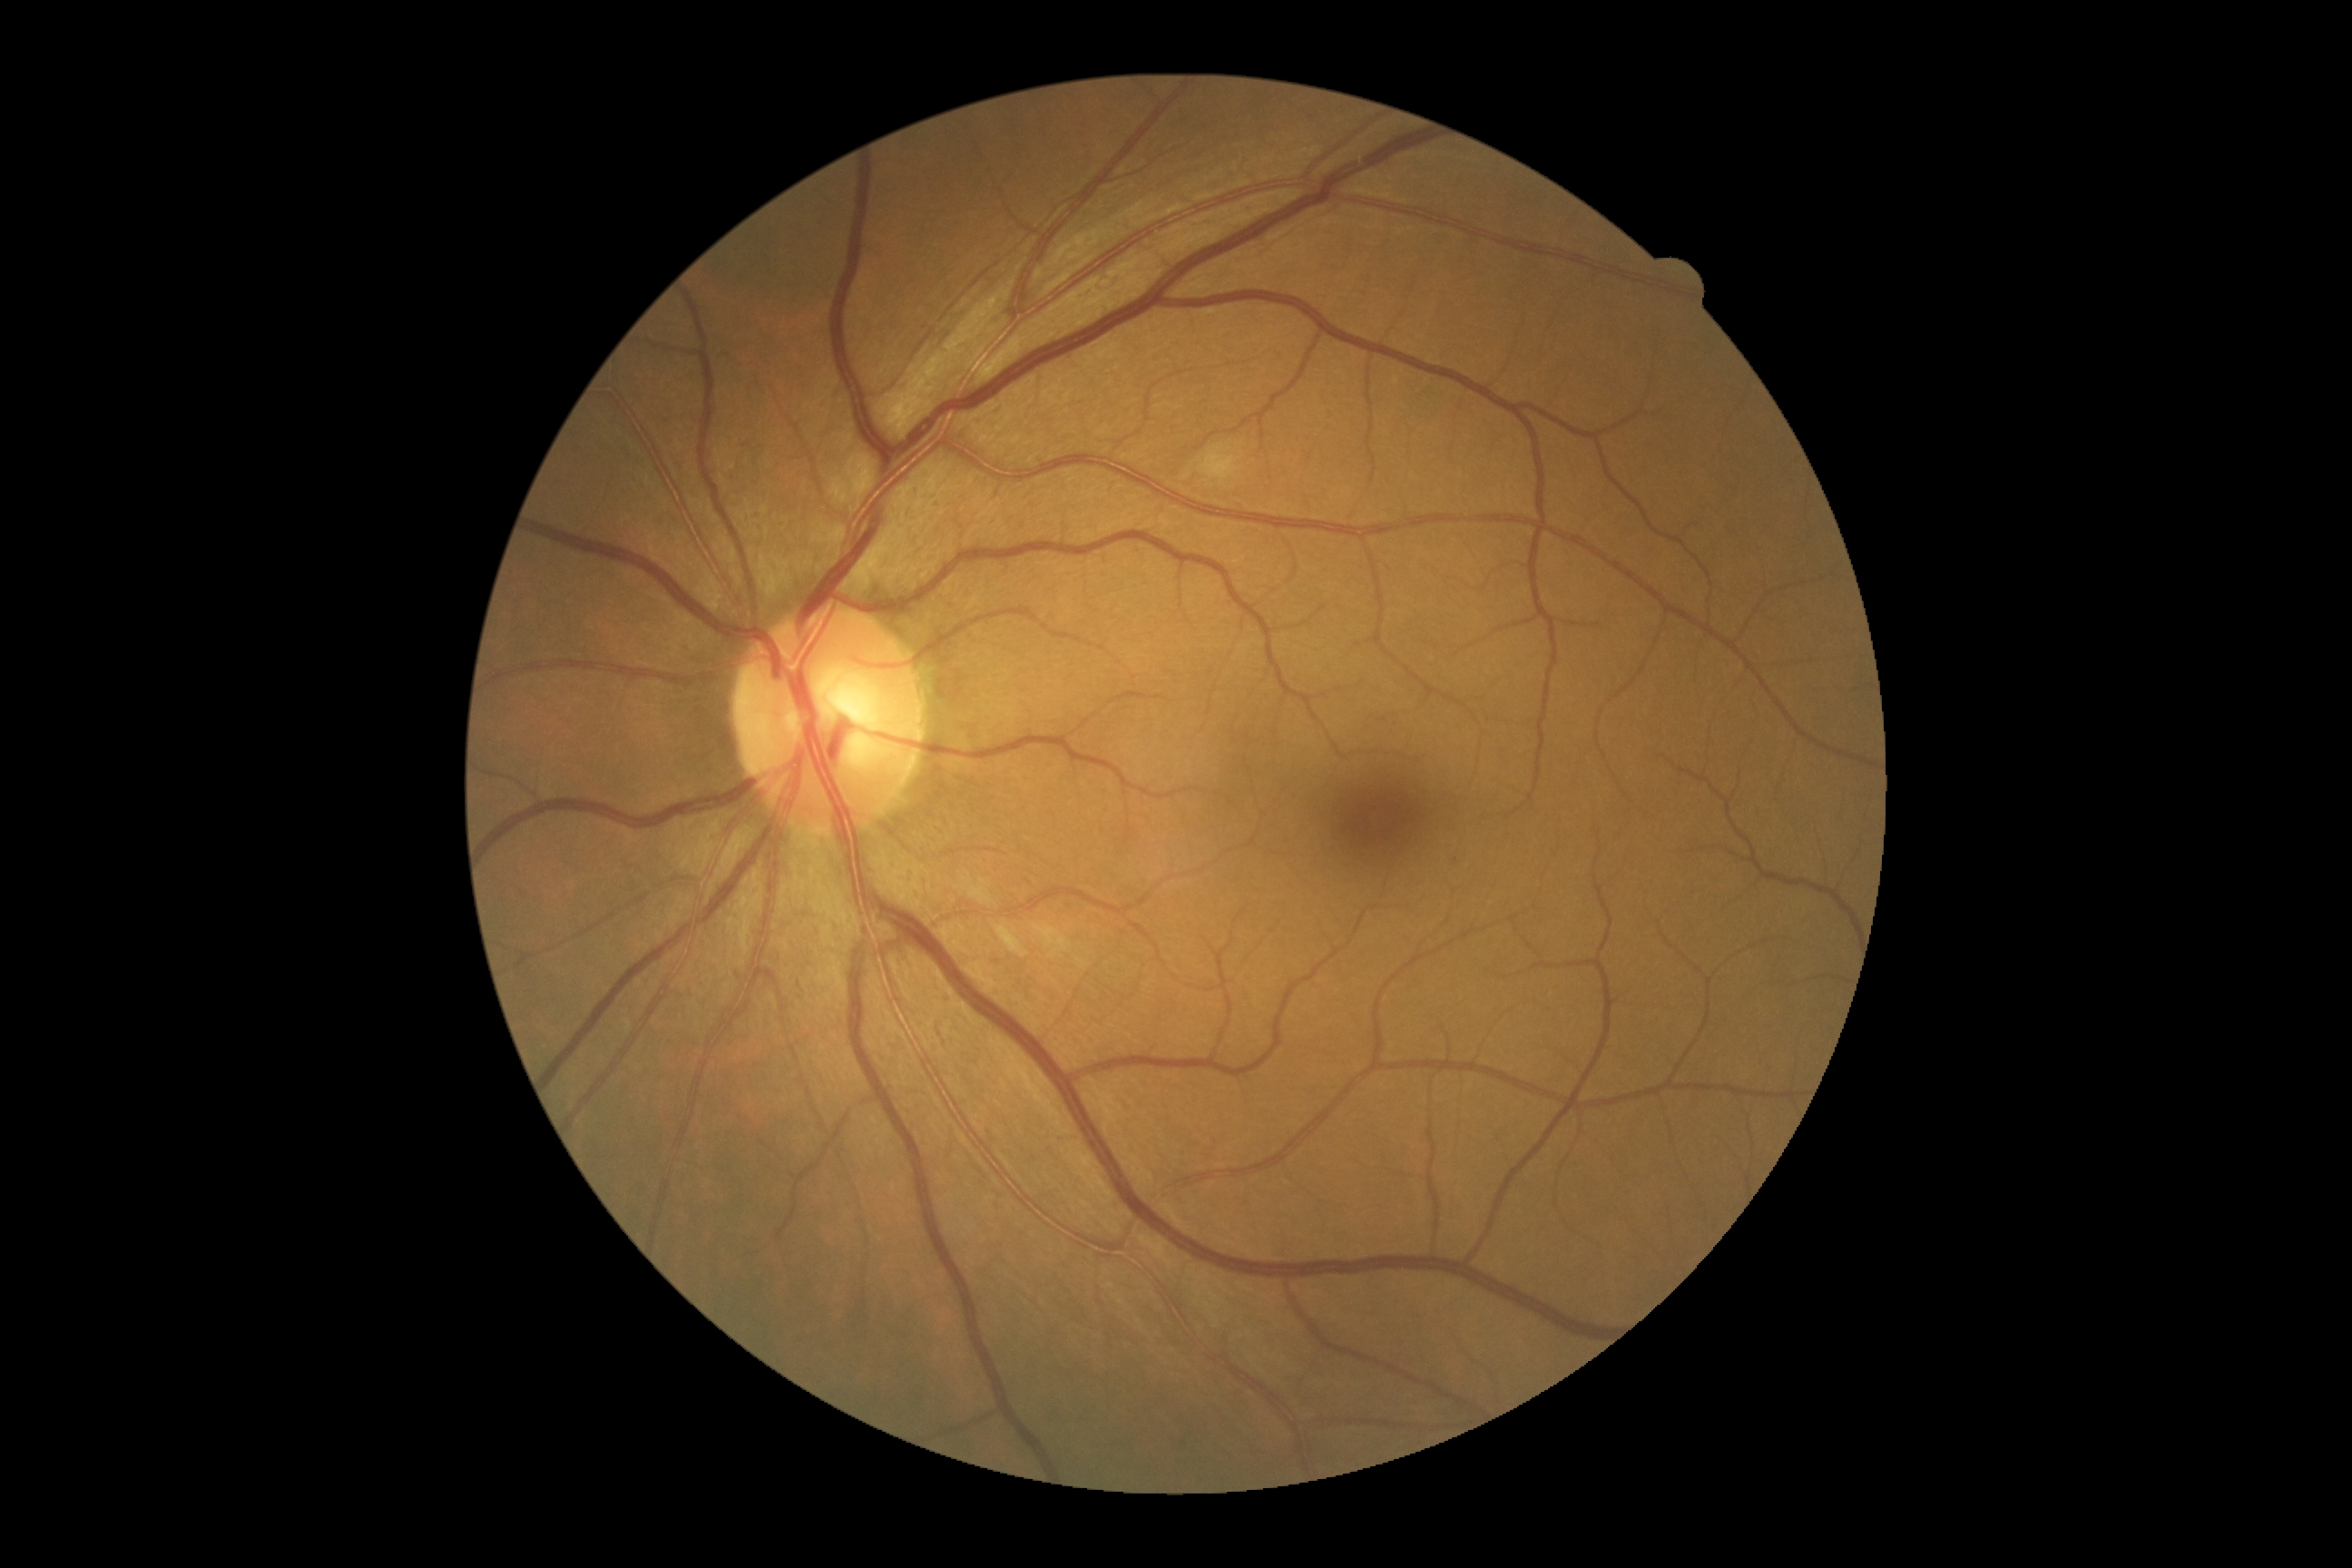

dr_grade: grade 2 (moderate NPDR)